2212x1659px, color fundus photograph from a handheld portable camera
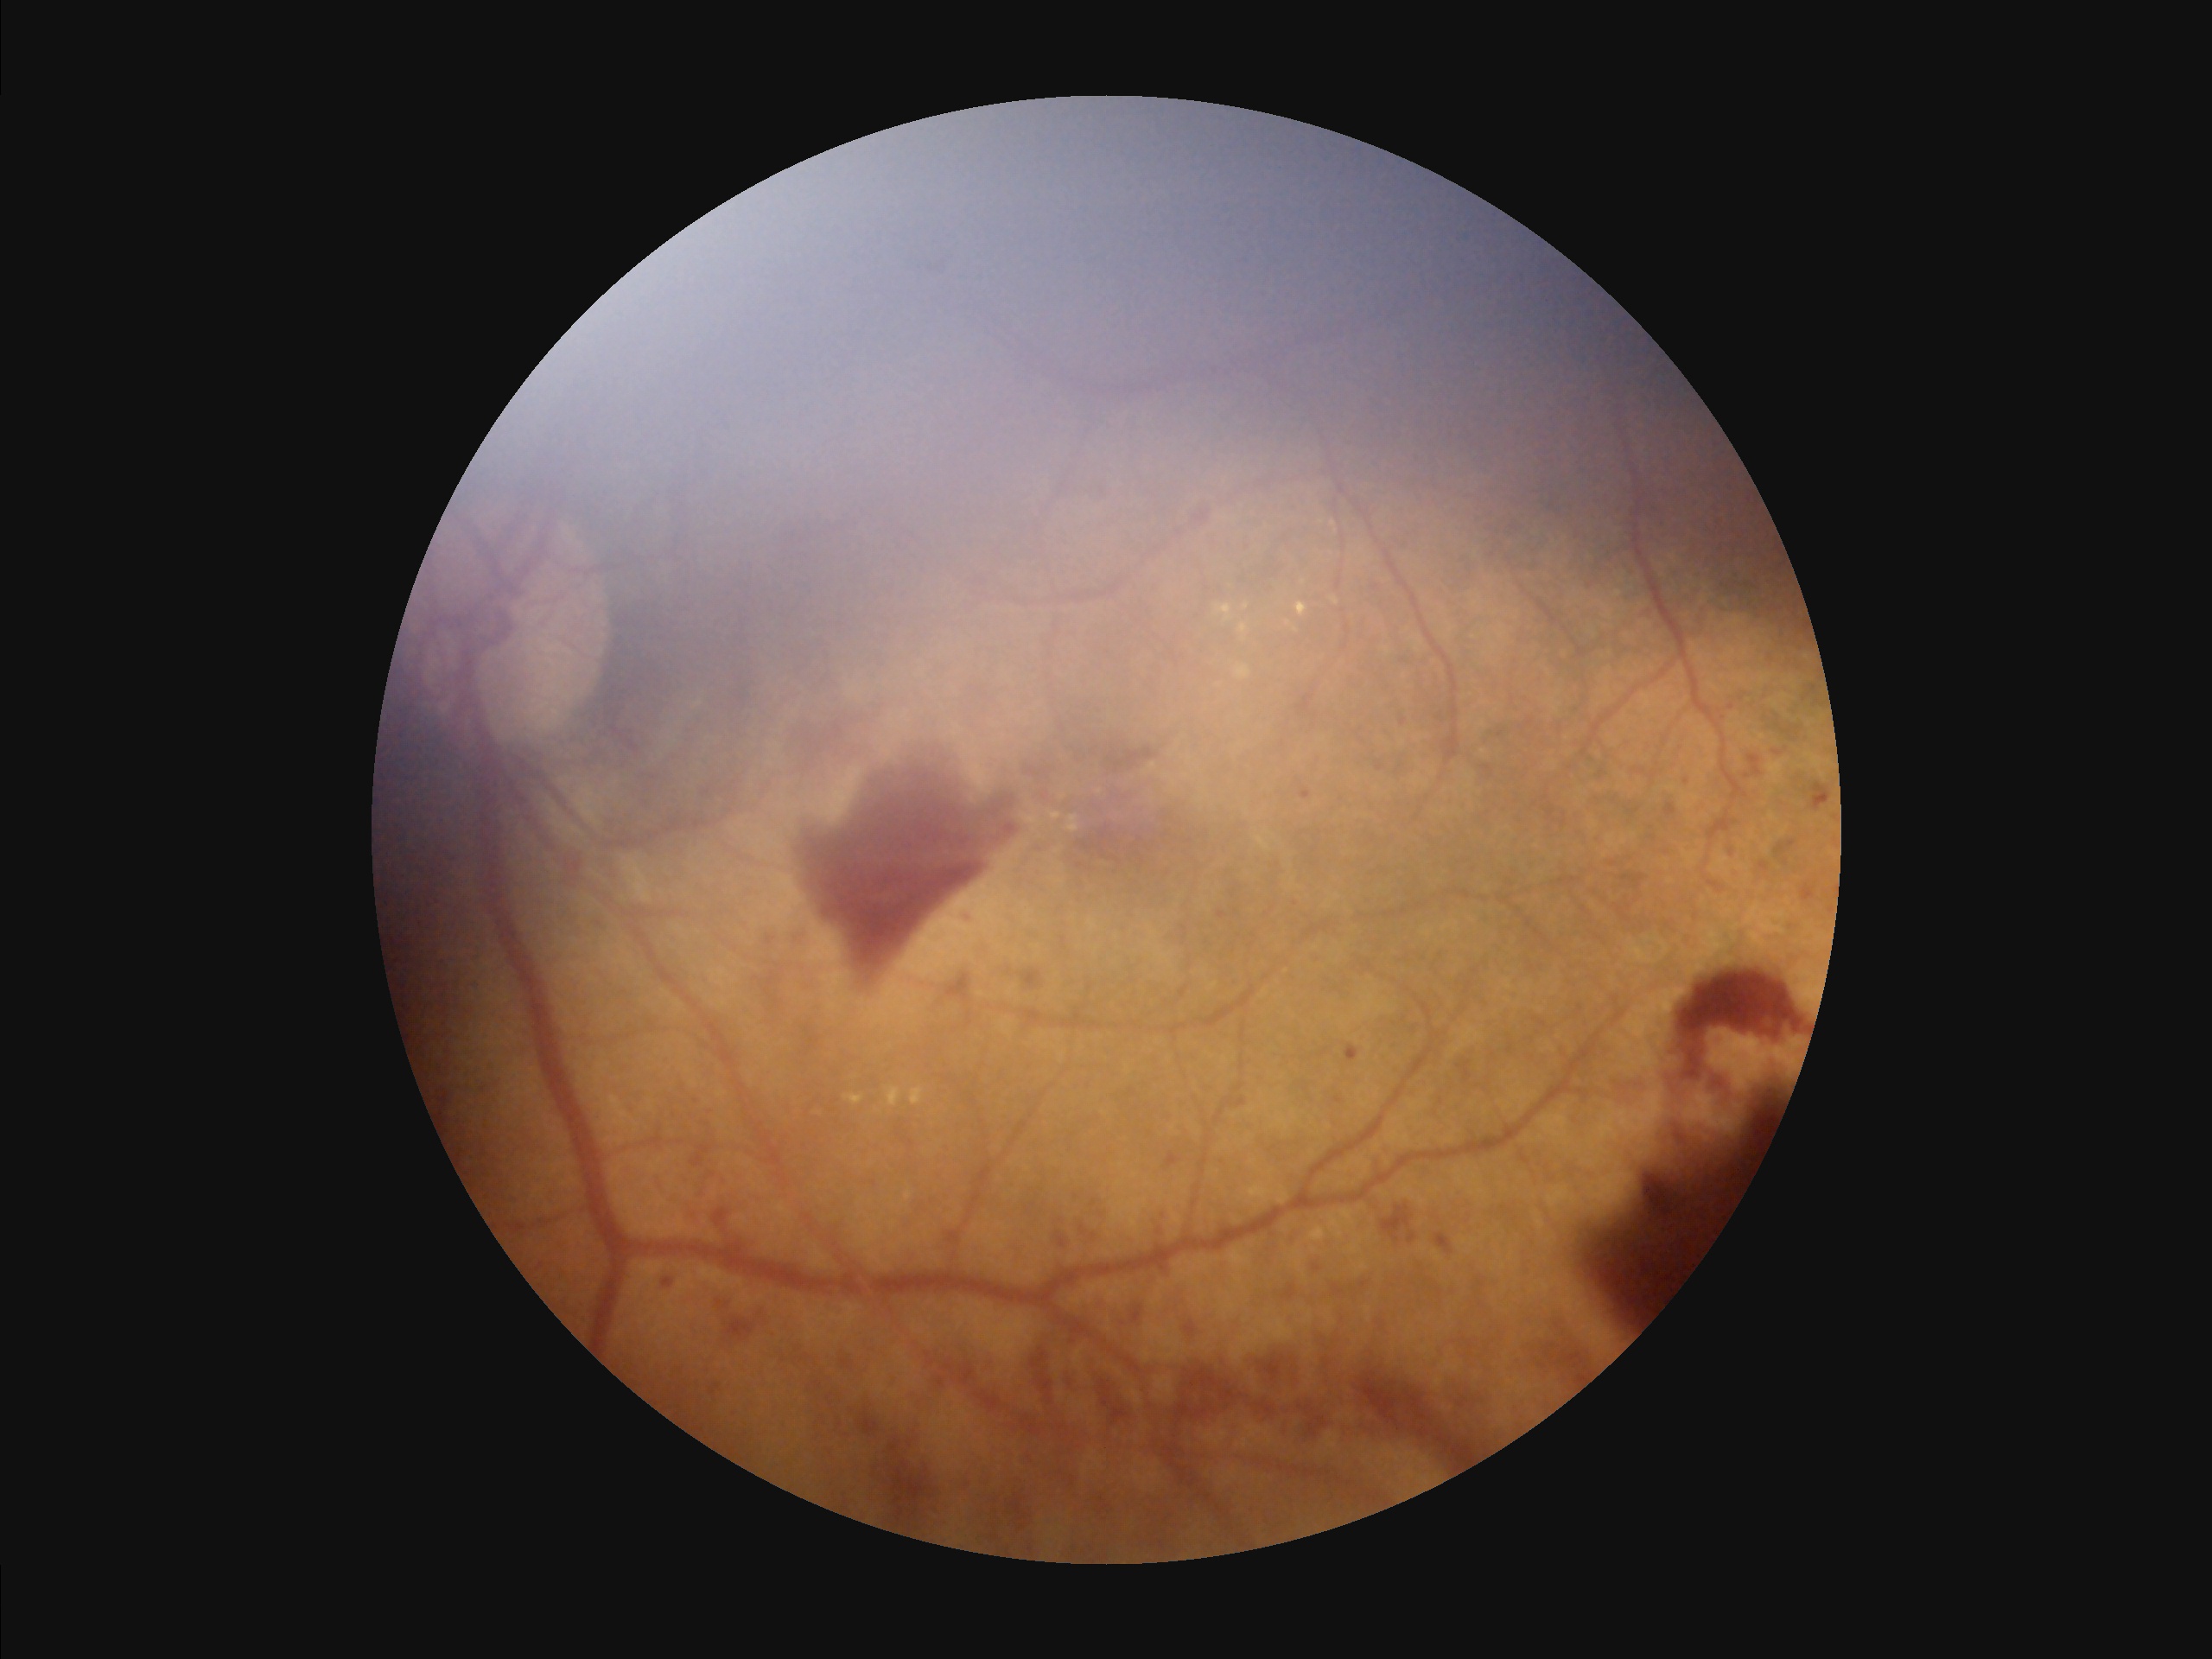
Contrast: wide intensity range, structures distinguishable
Overall quality: poor, ungradable
Focus: noticeable blur in the optic disc, vessels, or background
Illumination: inadequate, with uneven exposure or color distortion